Natus RetCam Envision, 130° FOV; RetCam wide-field infant fundus image:
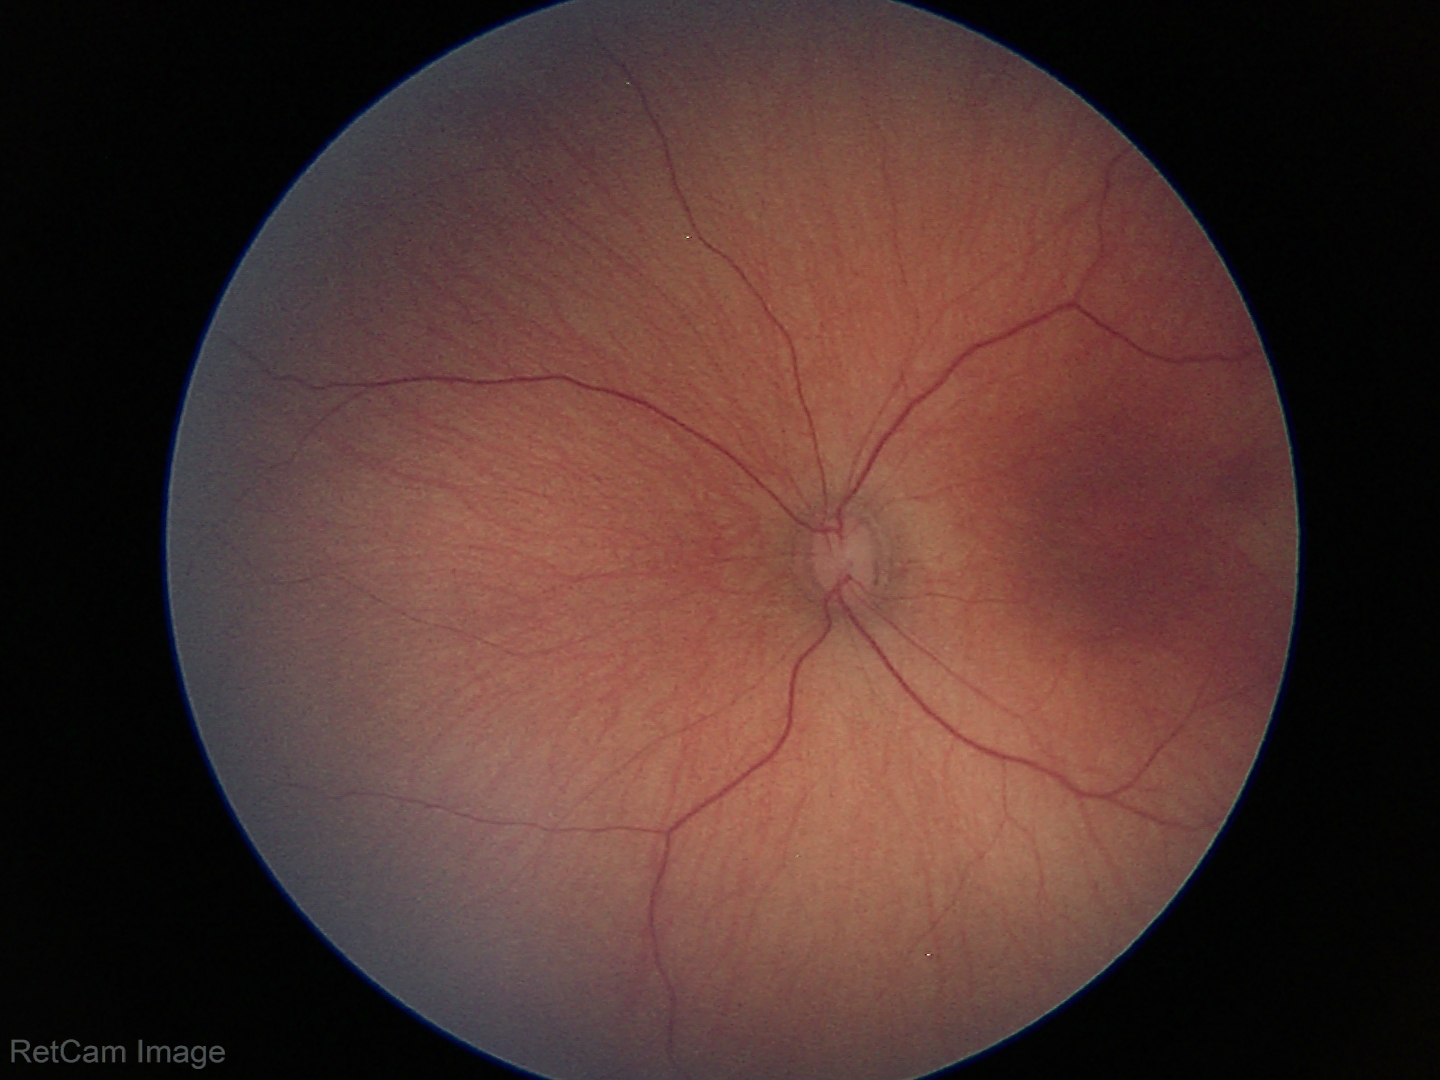
Q: What is the screening diagnosis?
A: normal retinal appearance